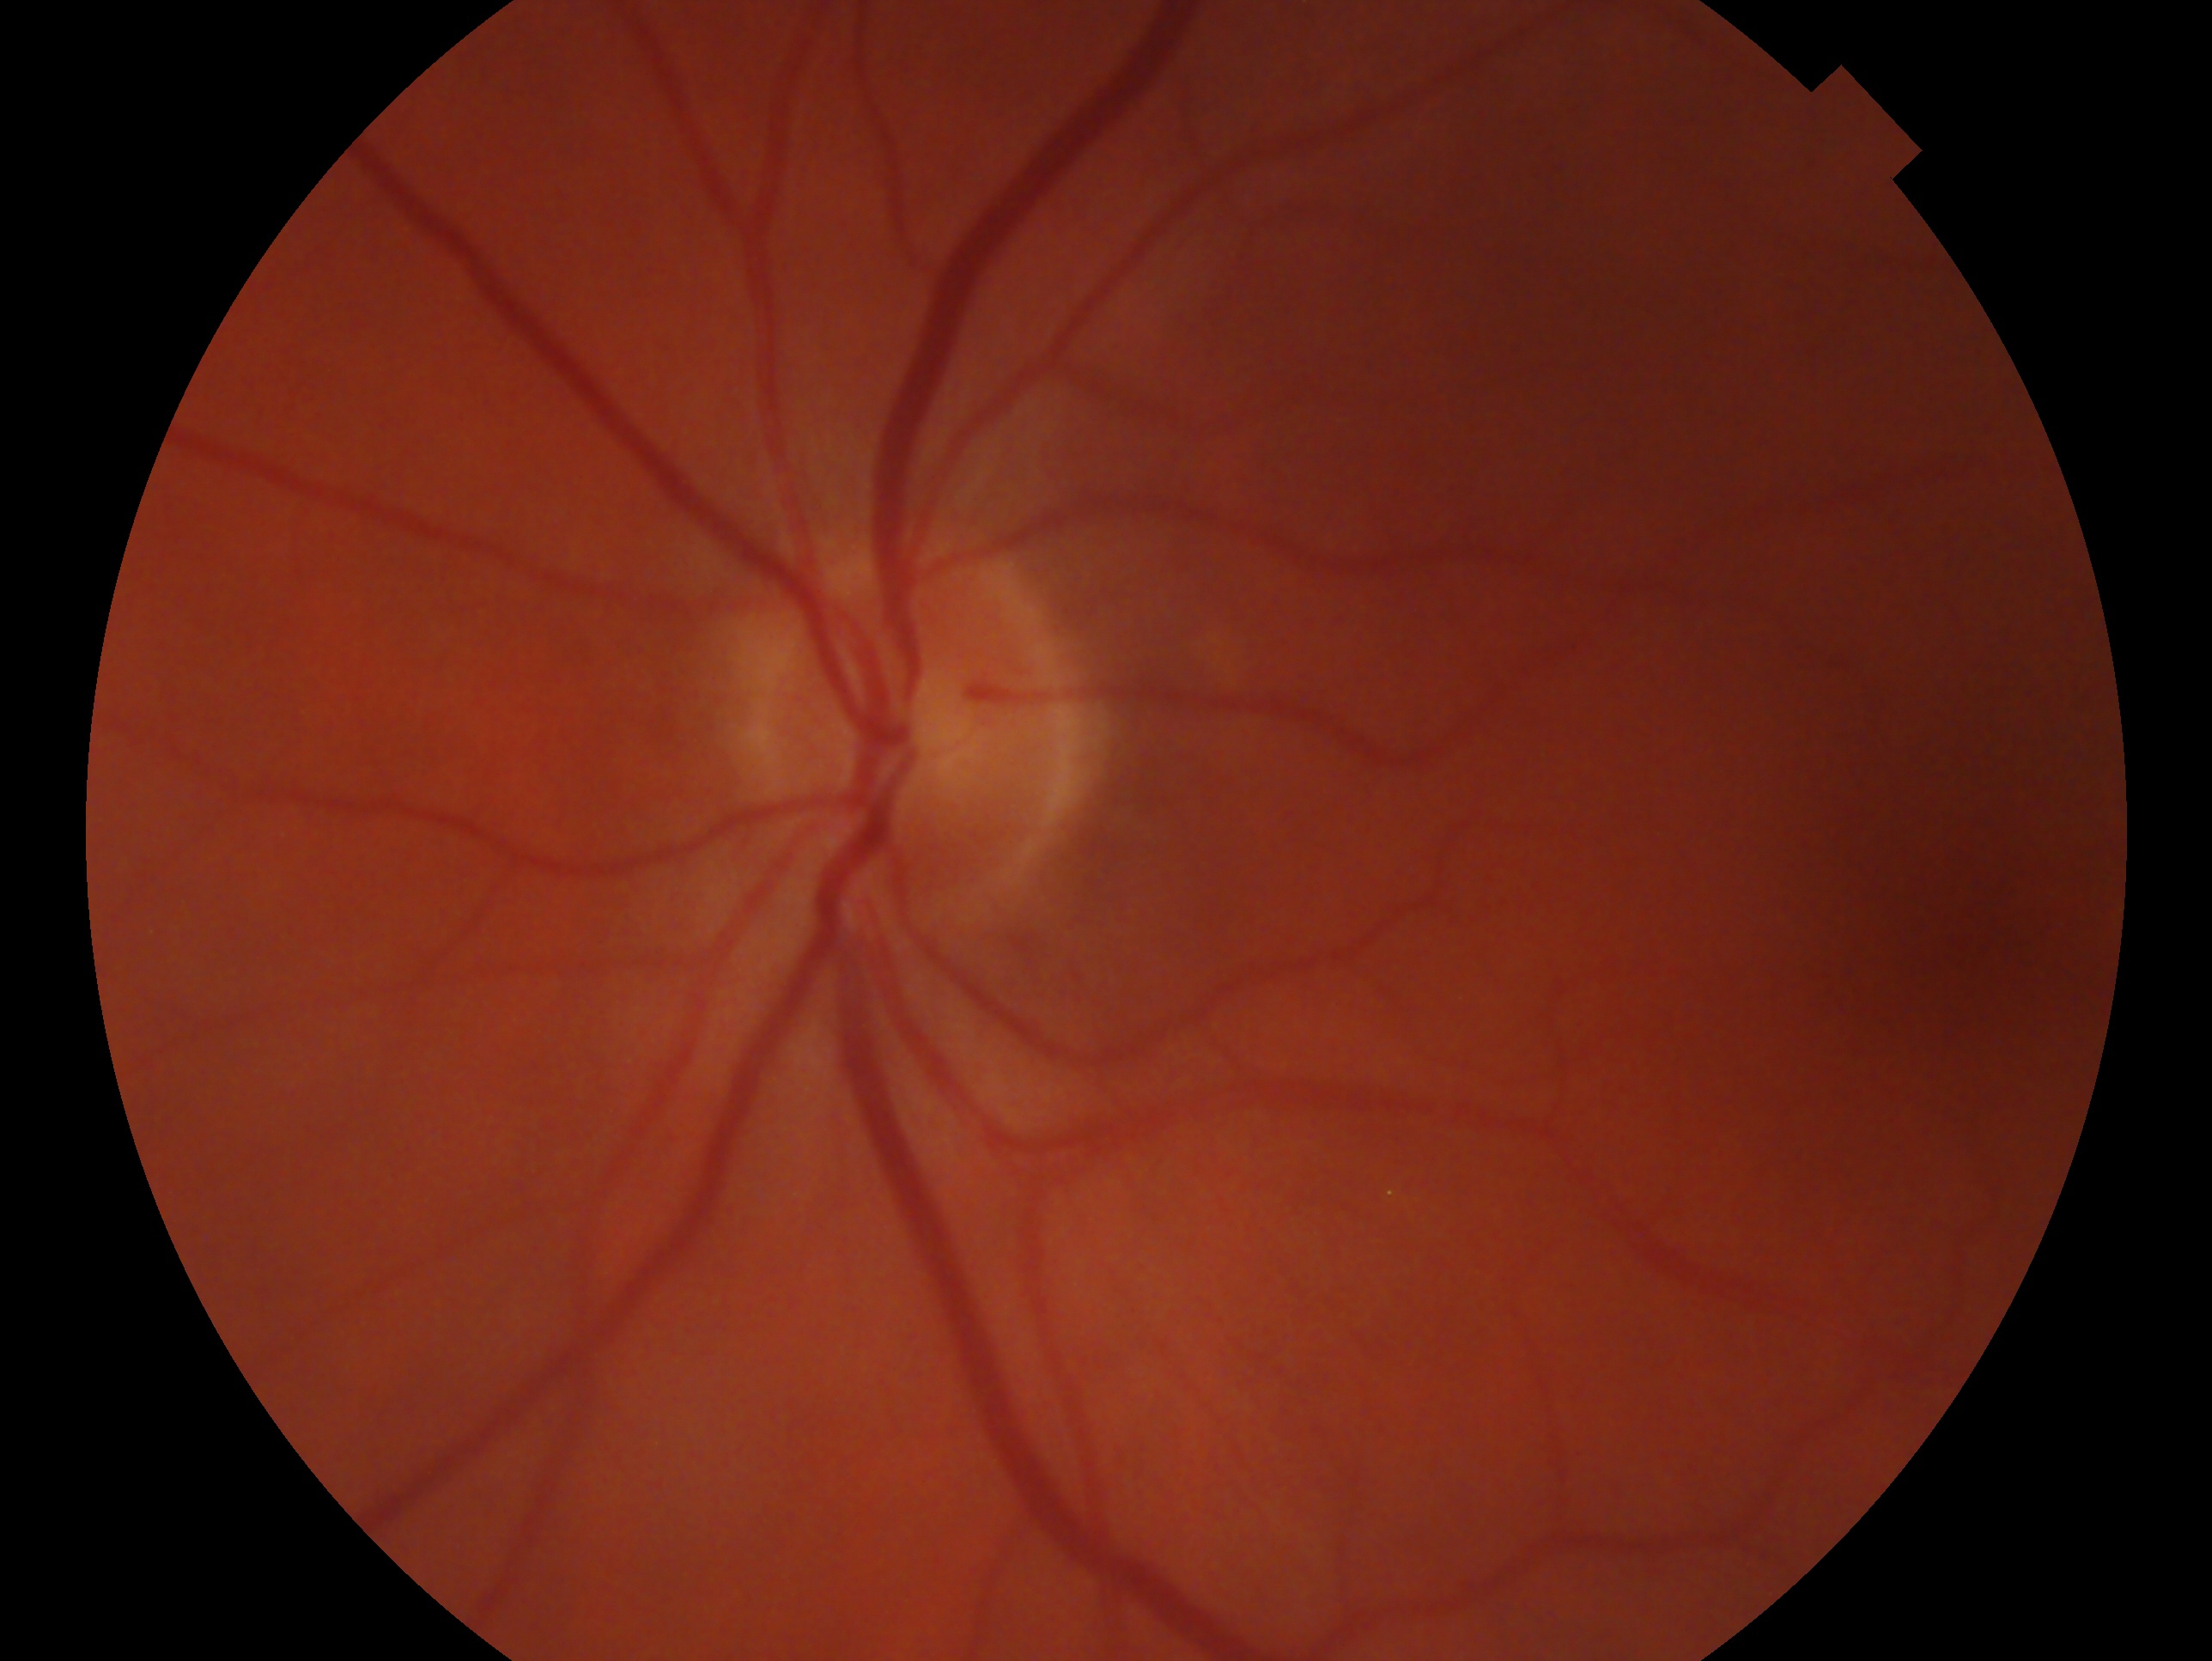

eye: left
glaucoma_dx: no glaucoma